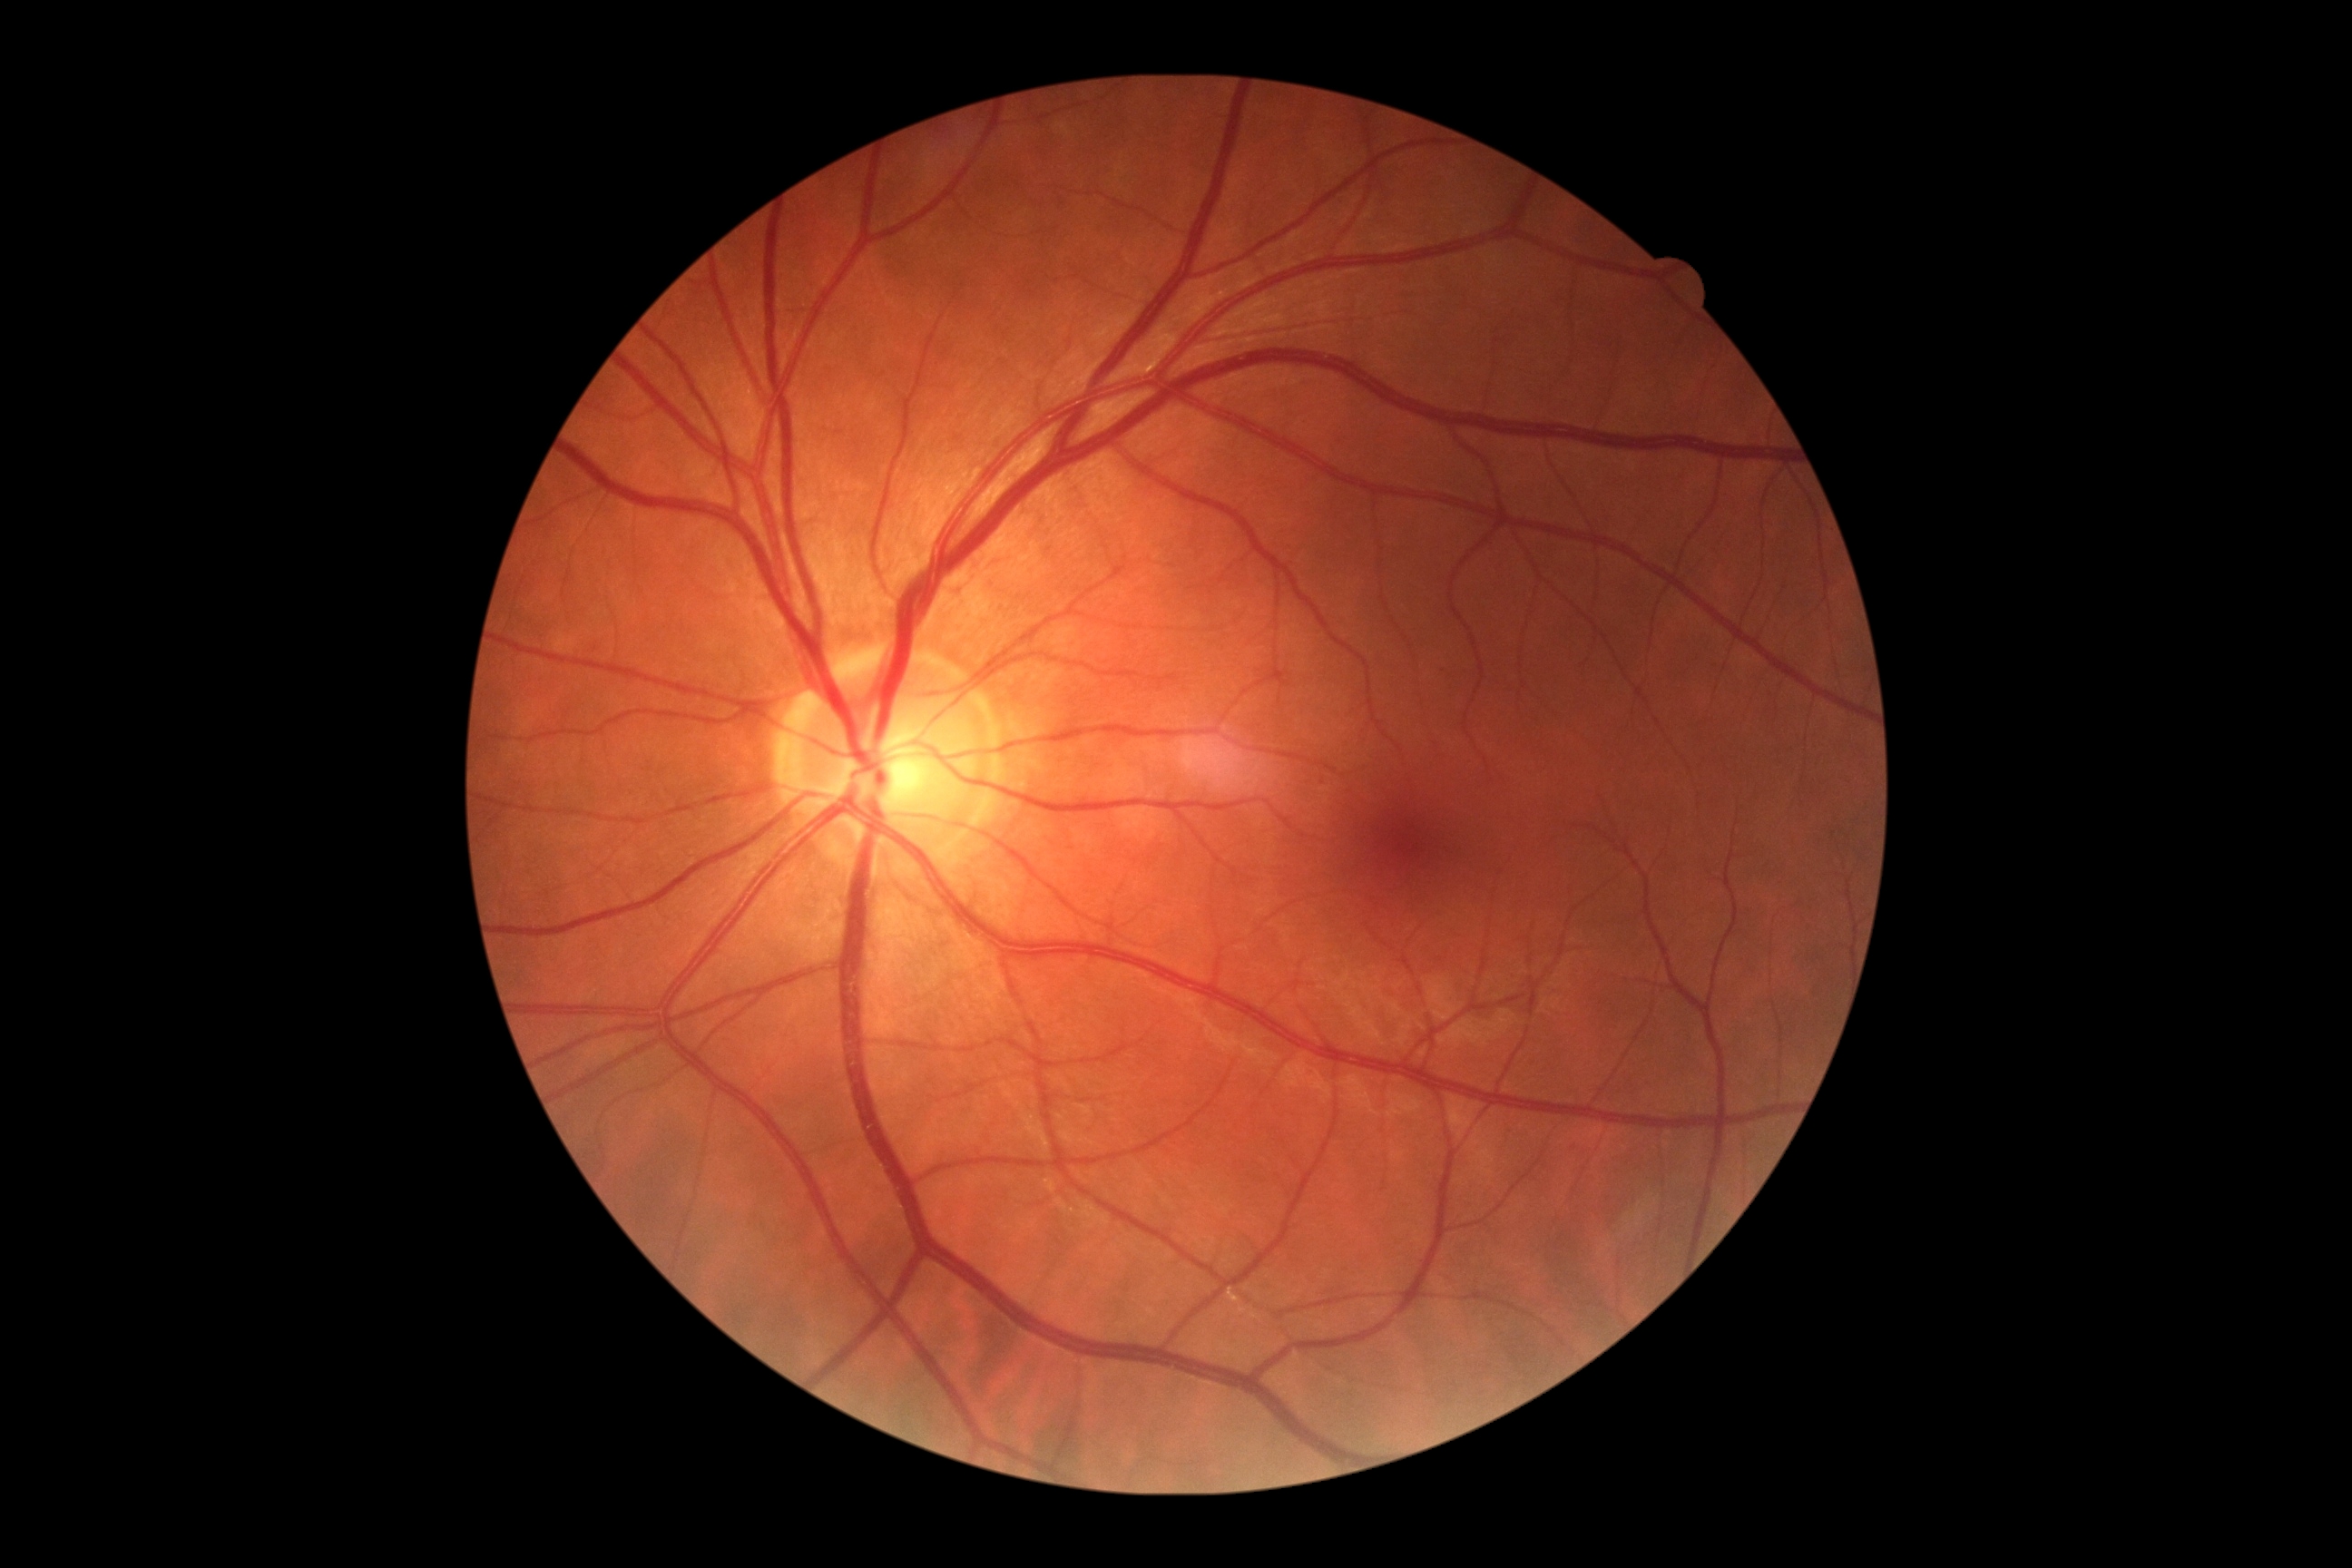
DR severity: grade 0 (no apparent retinopathy). No DR findings.